RetCam wide-field infant fundus image: 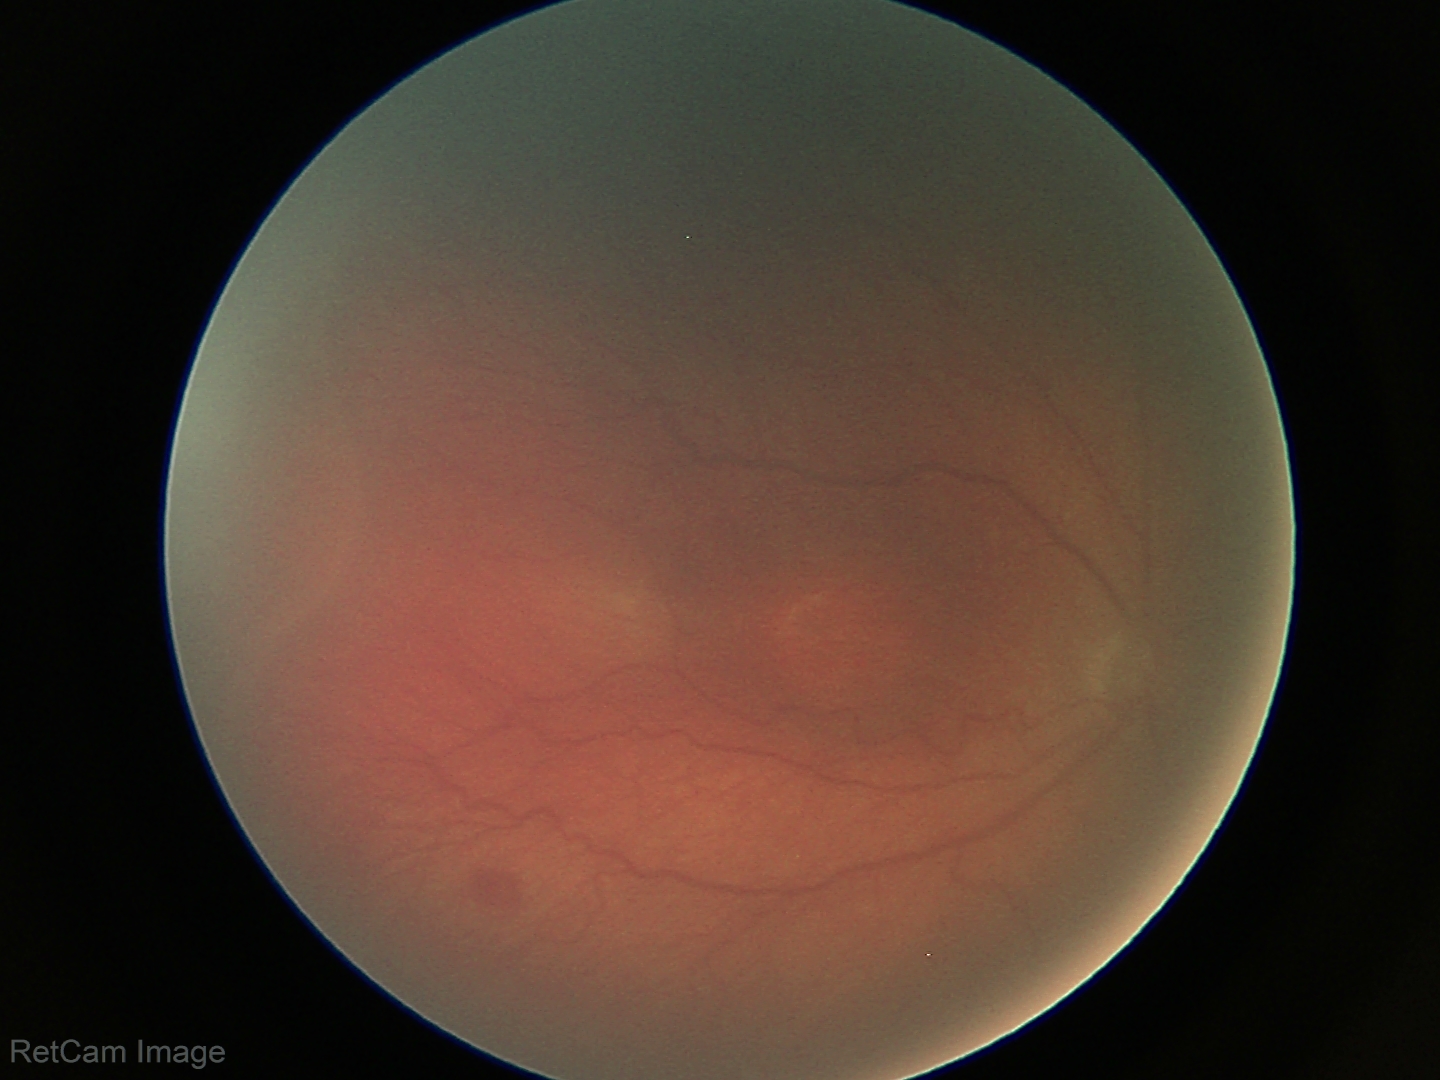 Series diagnosed as retinopathy of prematurity stage 3.
Plus disease absent.